Disc-centered fundus crop: 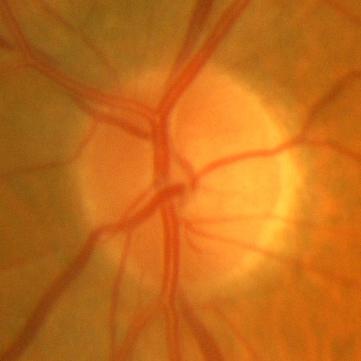 Q: Does this eye have glaucoma?
A: No — no evidence of glaucoma.